Optic nerve head photograph — 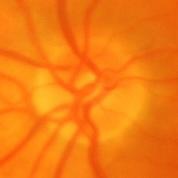 Glaucomatous changes are present. Impression = glaucomatous findings.